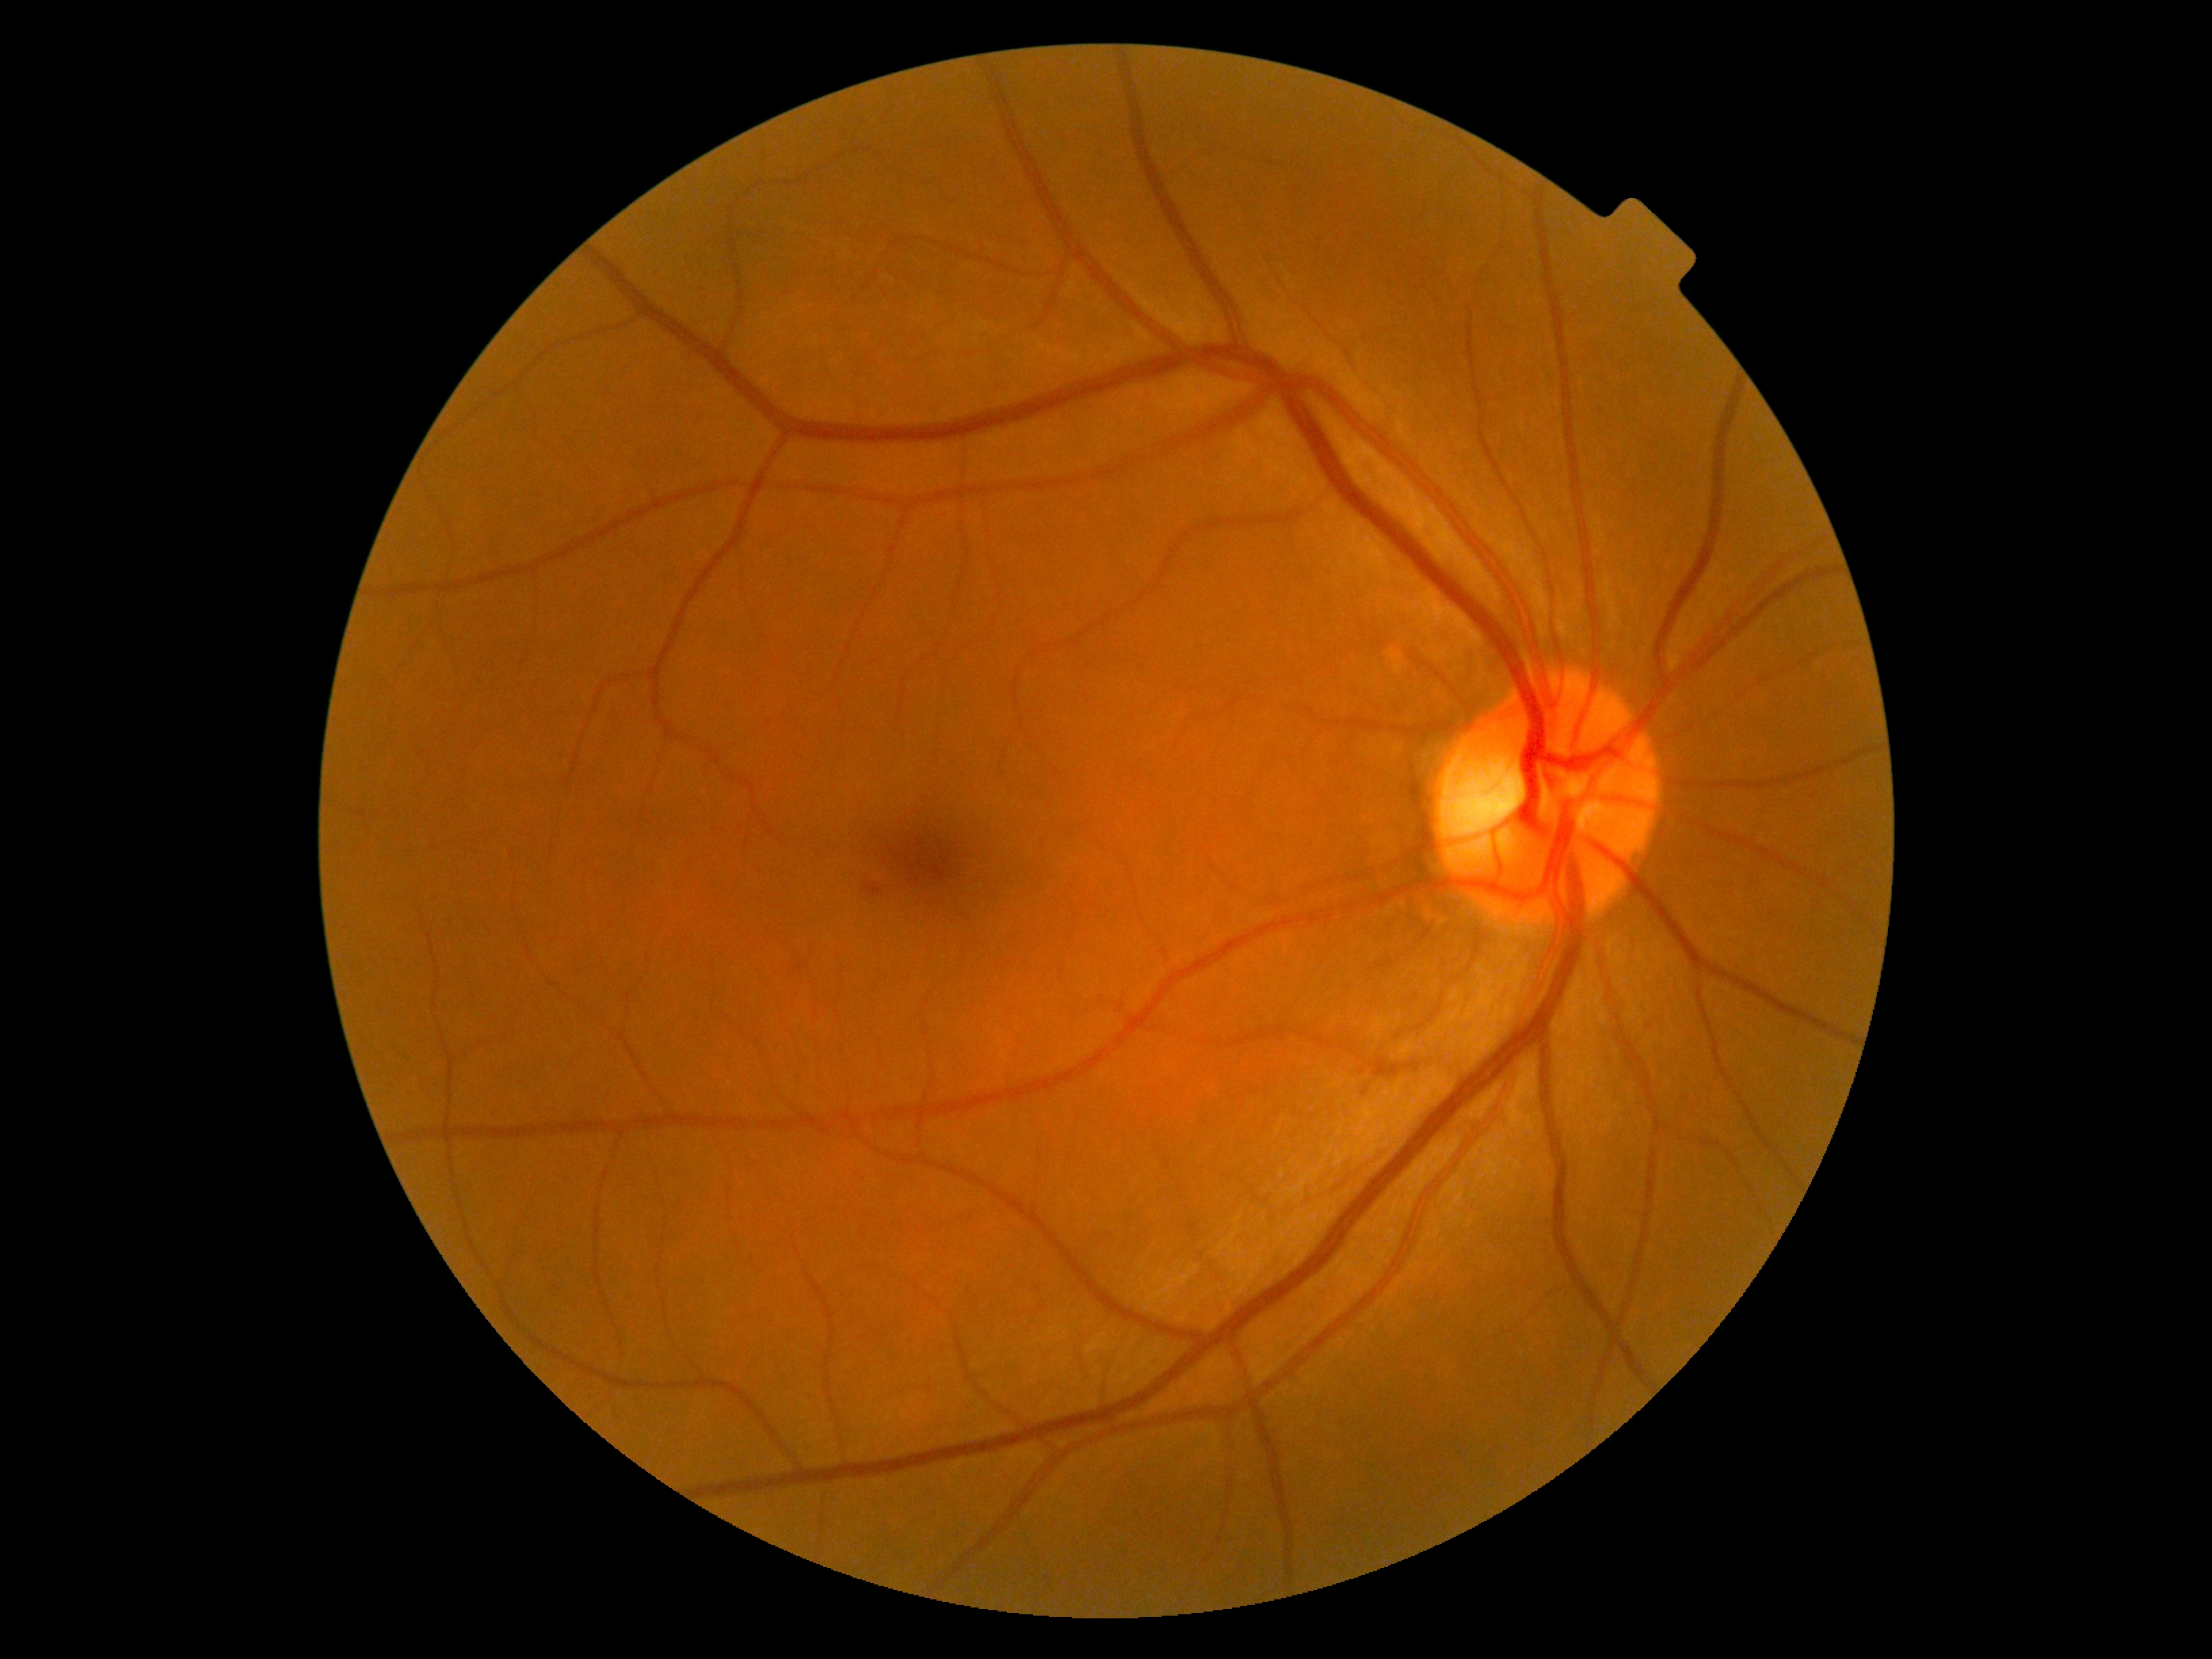 Findings:
– DR grade — moderate non-proliferative diabetic retinopathy (2)